Acquired with a Remidio smartphone fundus camera:
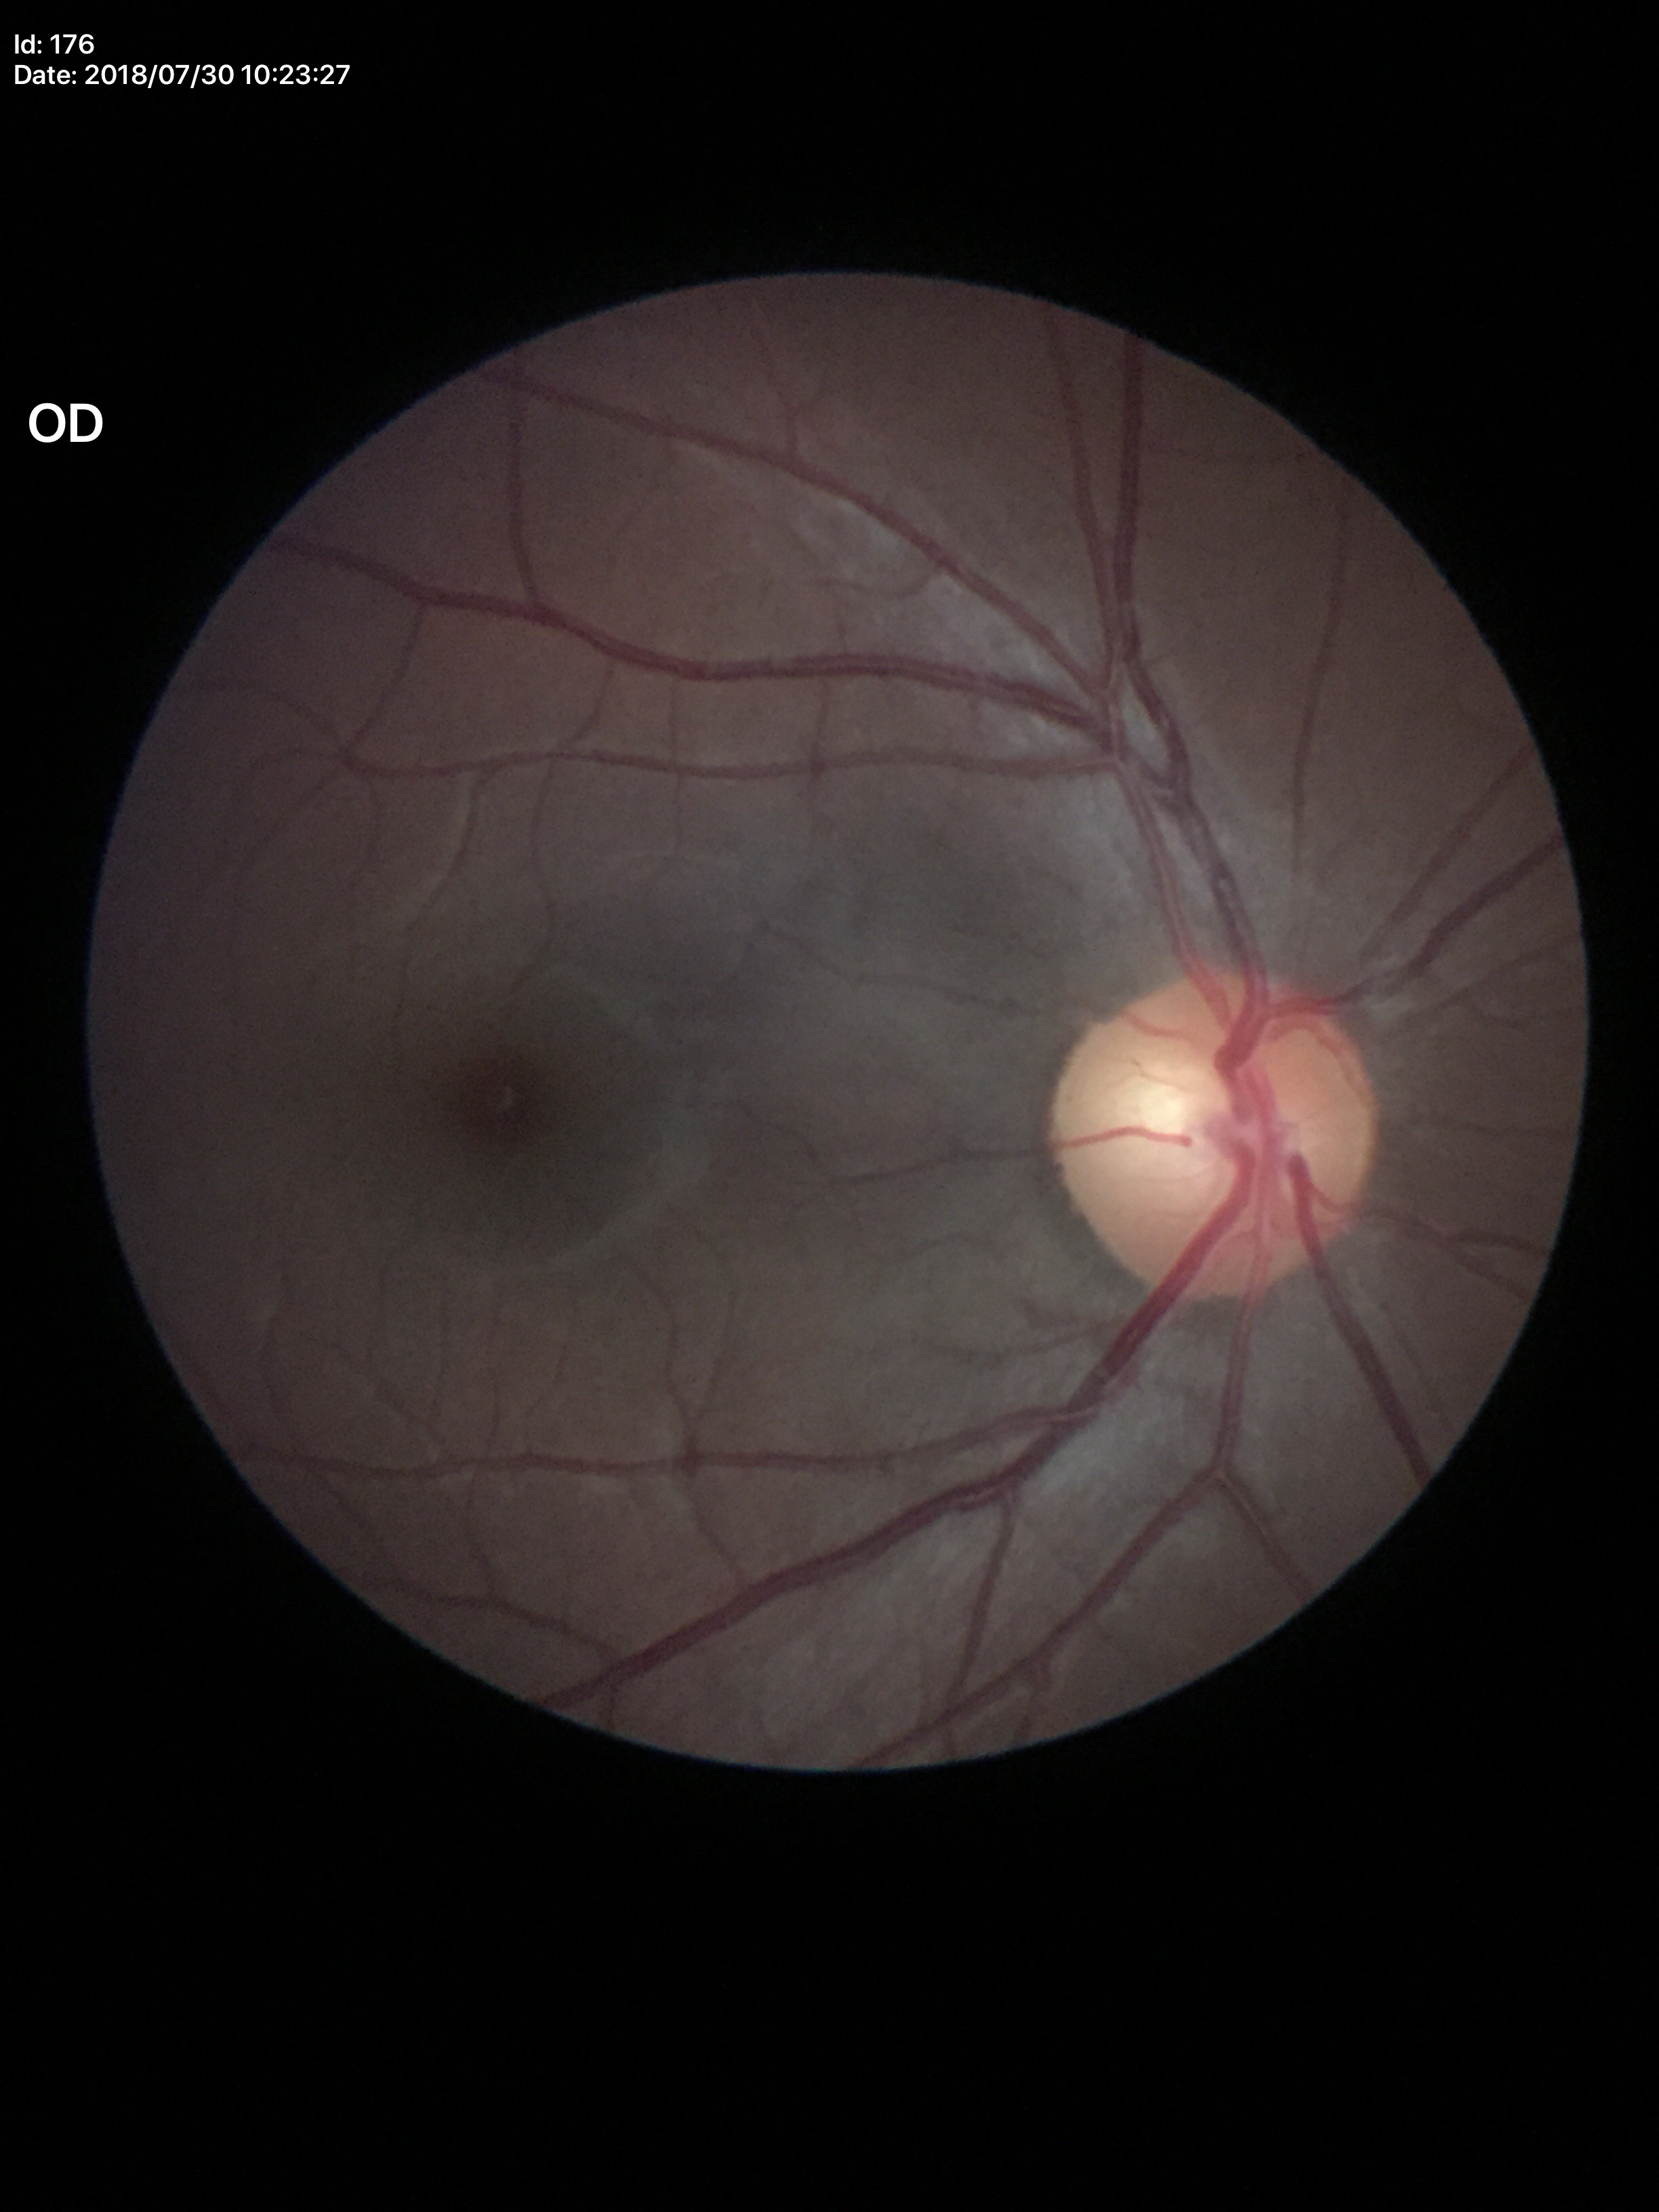
No glaucomatous optic neuropathy. Vertical CDR of 0.51.